1240x1240px. Phoenix ICON wide-field infant fundus image
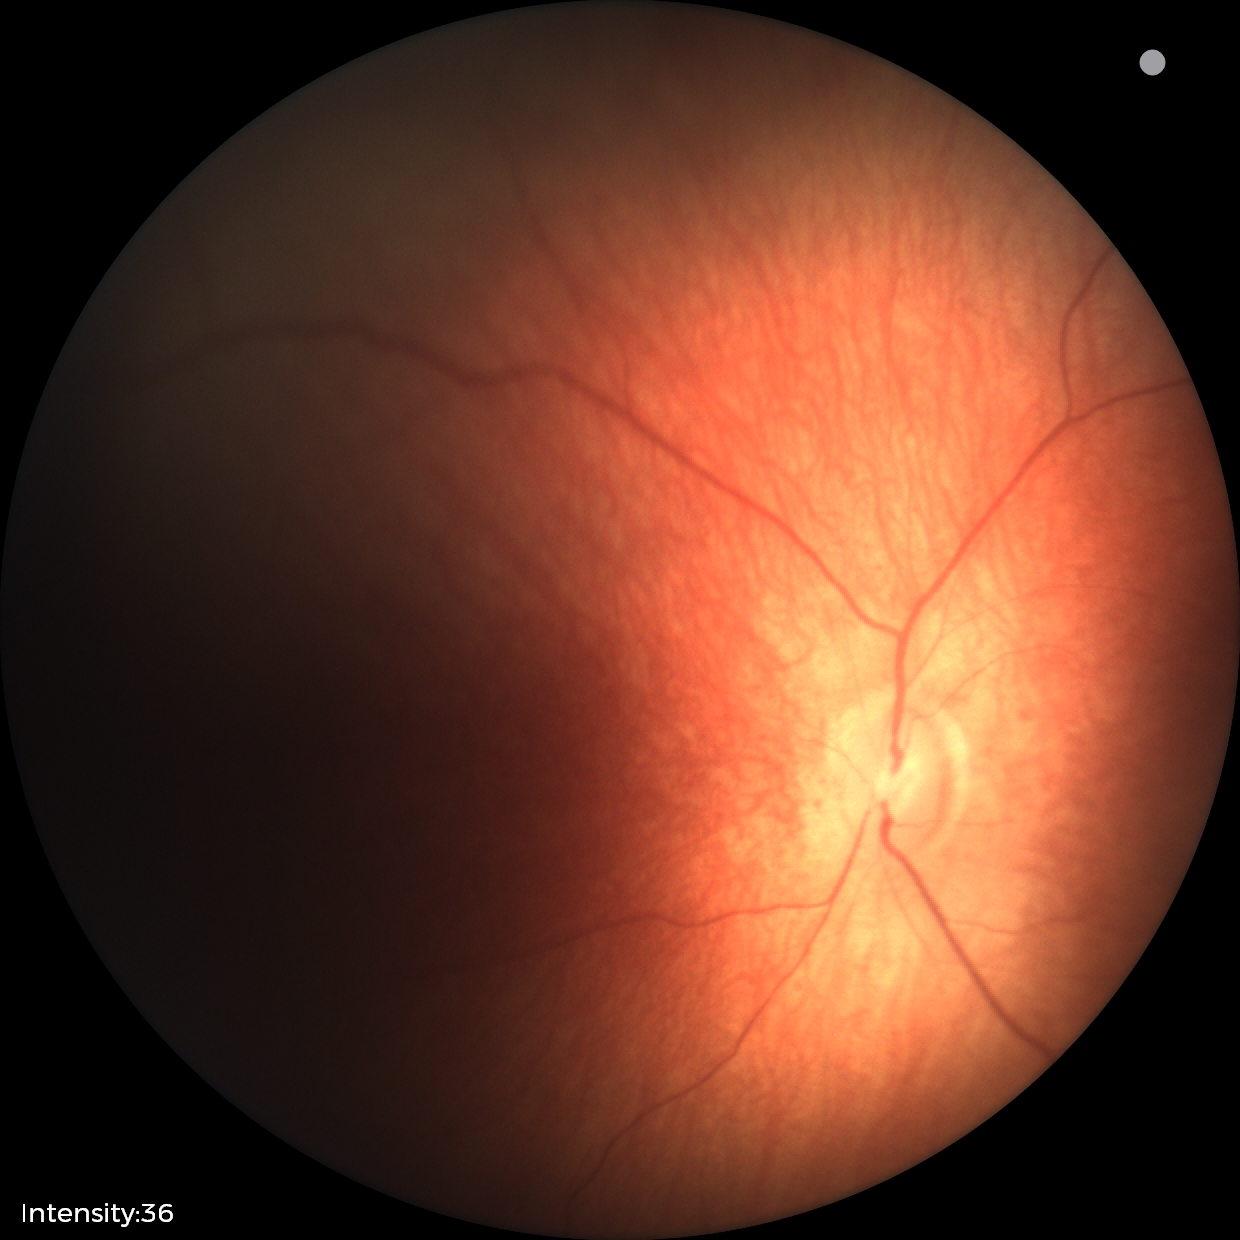

Screening examination diagnosed as physiological.